Retinal fundus photograph; 2212 by 1659 pixels.
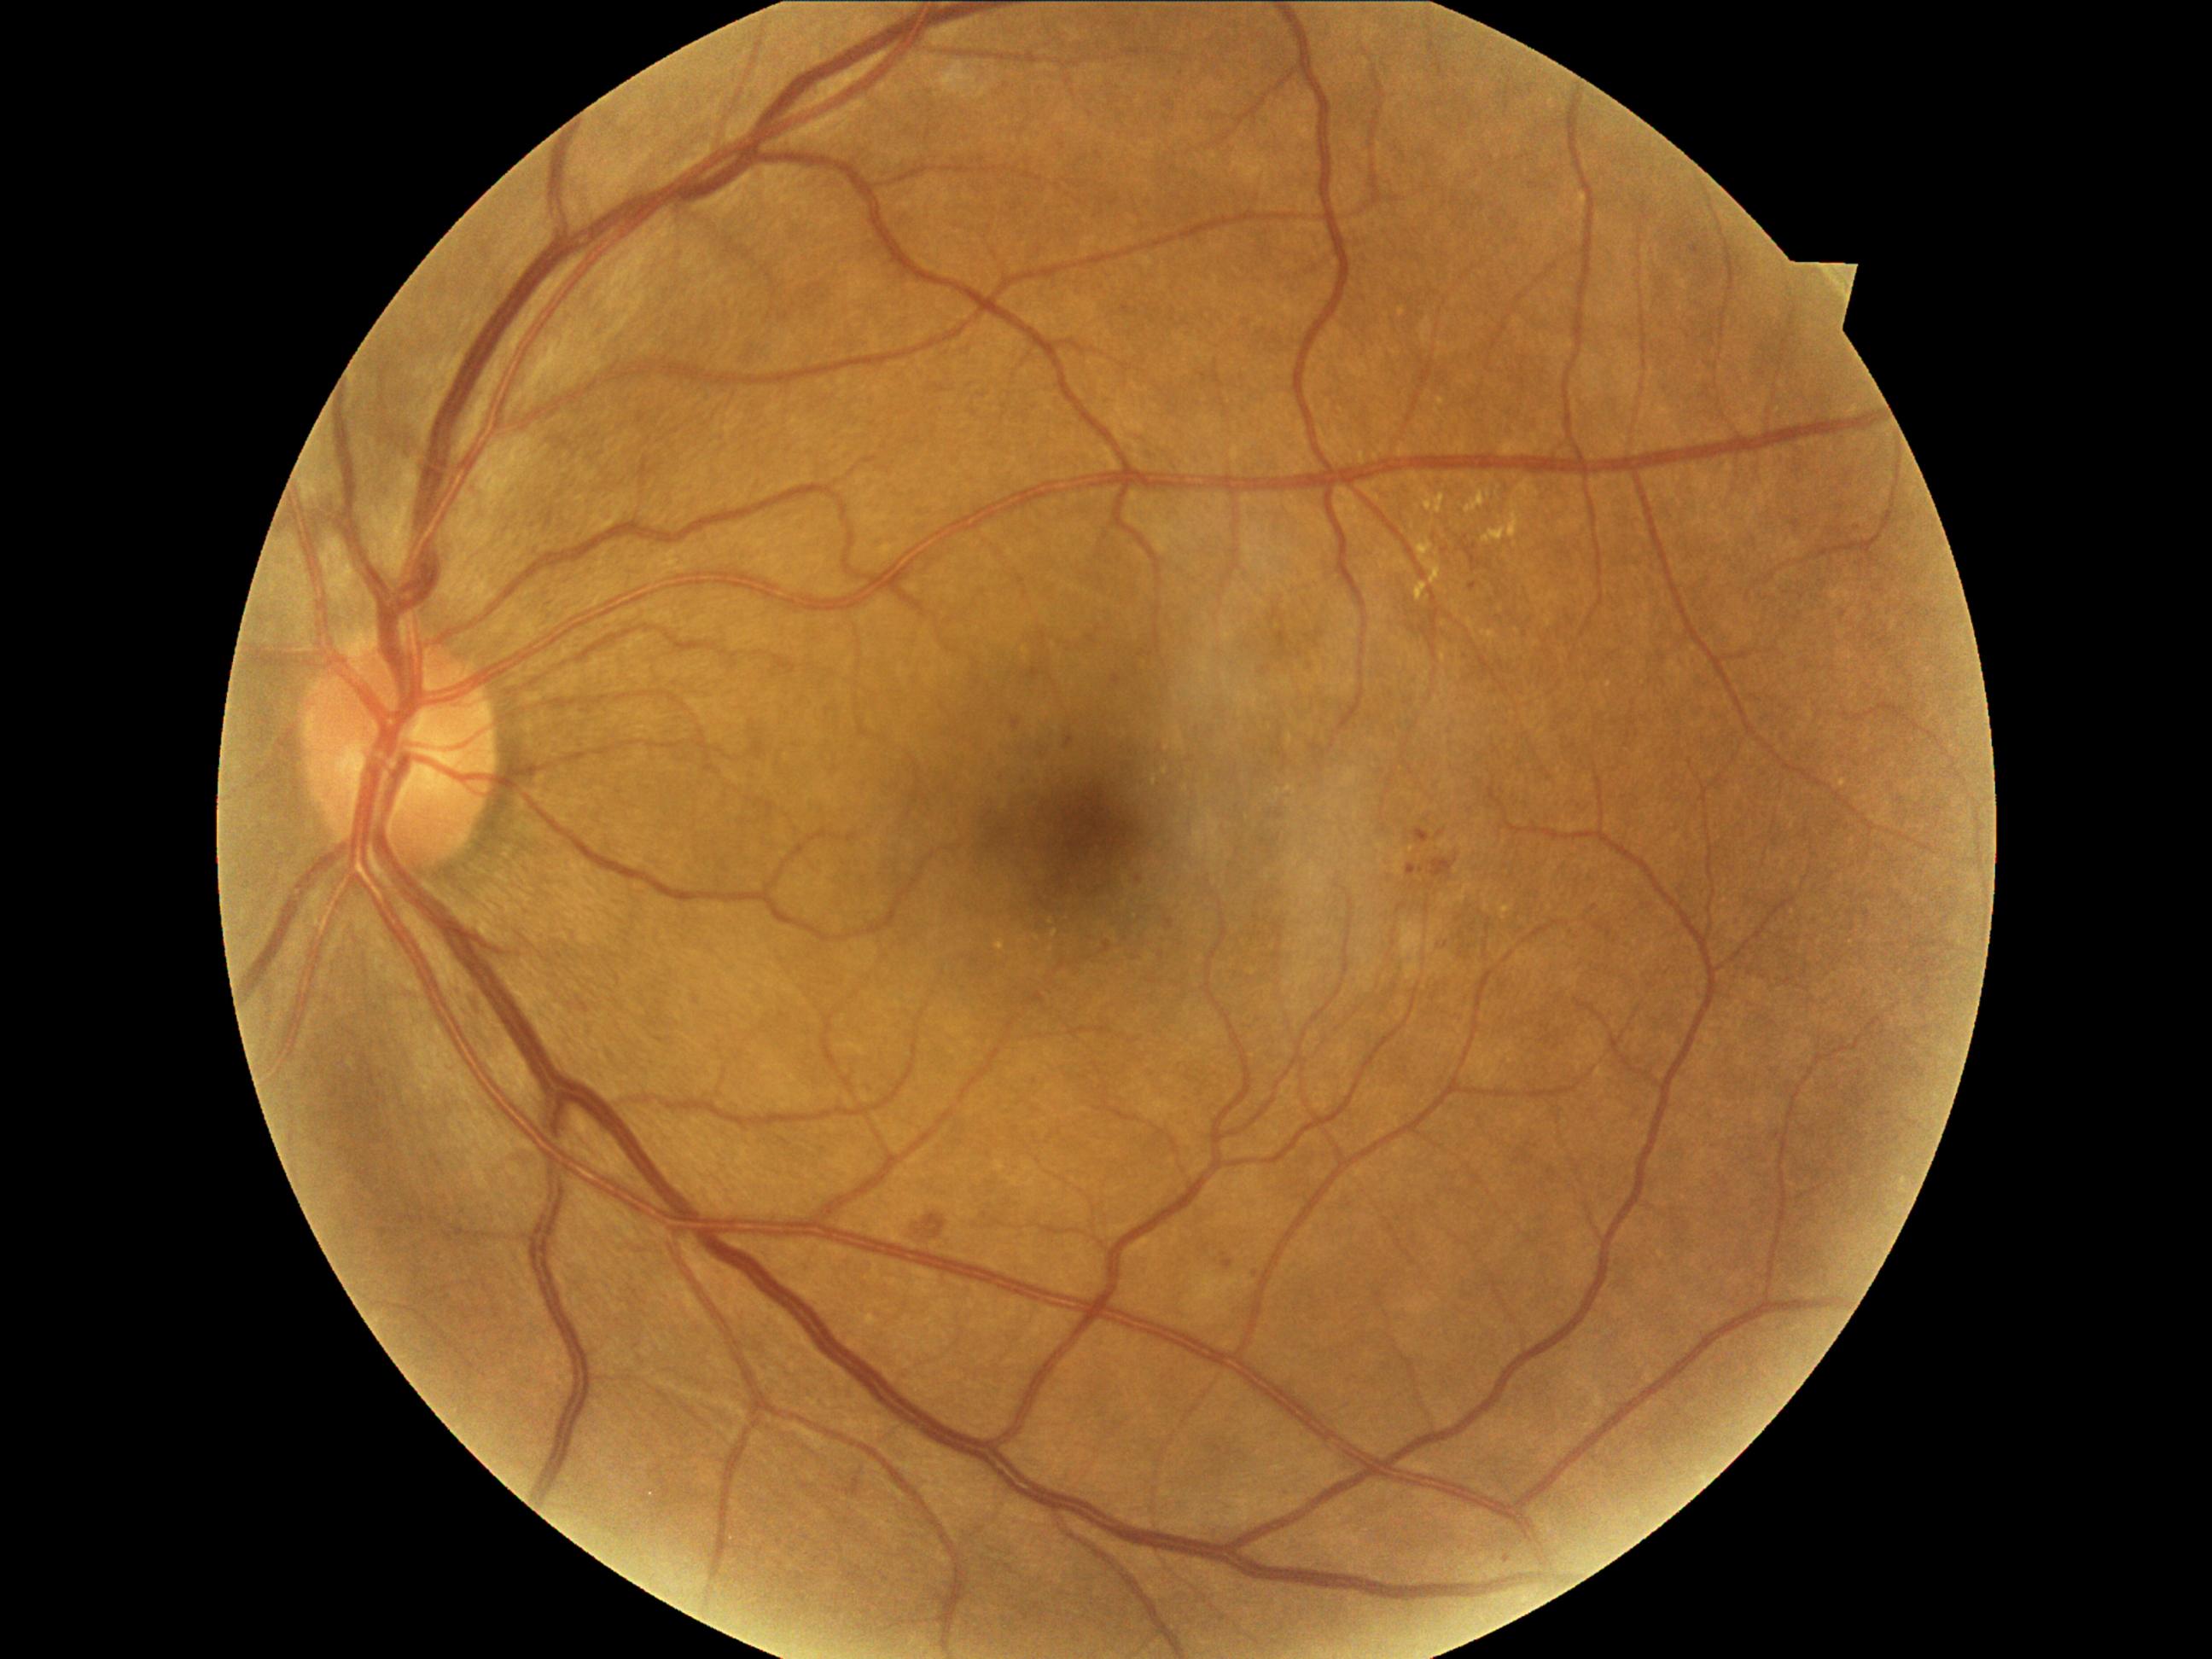 Diabetic retinopathy grade is moderate non-proliferative diabetic retinopathy (2).
Hard exudates include region(1416, 538, 1441, 585) | region(1501, 905, 1511, 914) | region(1416, 583, 1428, 602) | region(1467, 492, 1486, 515) | region(1839, 779, 1846, 788).
Small hard exudates approximately at [1037, 938] | [1155, 780] | [1515, 545] | [1400, 857] | [1487, 907].
Hemorrhages include region(1011, 719, 1020, 730) | region(583, 1004, 590, 1013) | region(904, 1211, 950, 1245) | region(757, 1361, 771, 1373) | region(1028, 668, 1044, 680) | region(1165, 919, 1173, 929) | region(696, 996, 701, 1004) | region(1414, 829, 1429, 844) | region(1148, 981, 1156, 984) | region(1114, 675, 1122, 685) | region(1566, 929, 1581, 943) | region(1016, 776, 1028, 786) | region(1102, 943, 1112, 953) | region(1470, 583, 1479, 591) | region(1223, 1259, 1233, 1269).
Small hemorrhages approximately at [1776, 1135] | [1035, 1082] | [1507, 1560] | [1162, 955].